Camera: Nidek AFC-330.
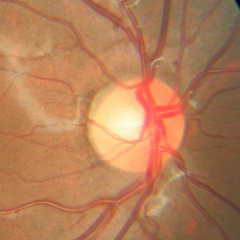 Impression: no glaucoma.